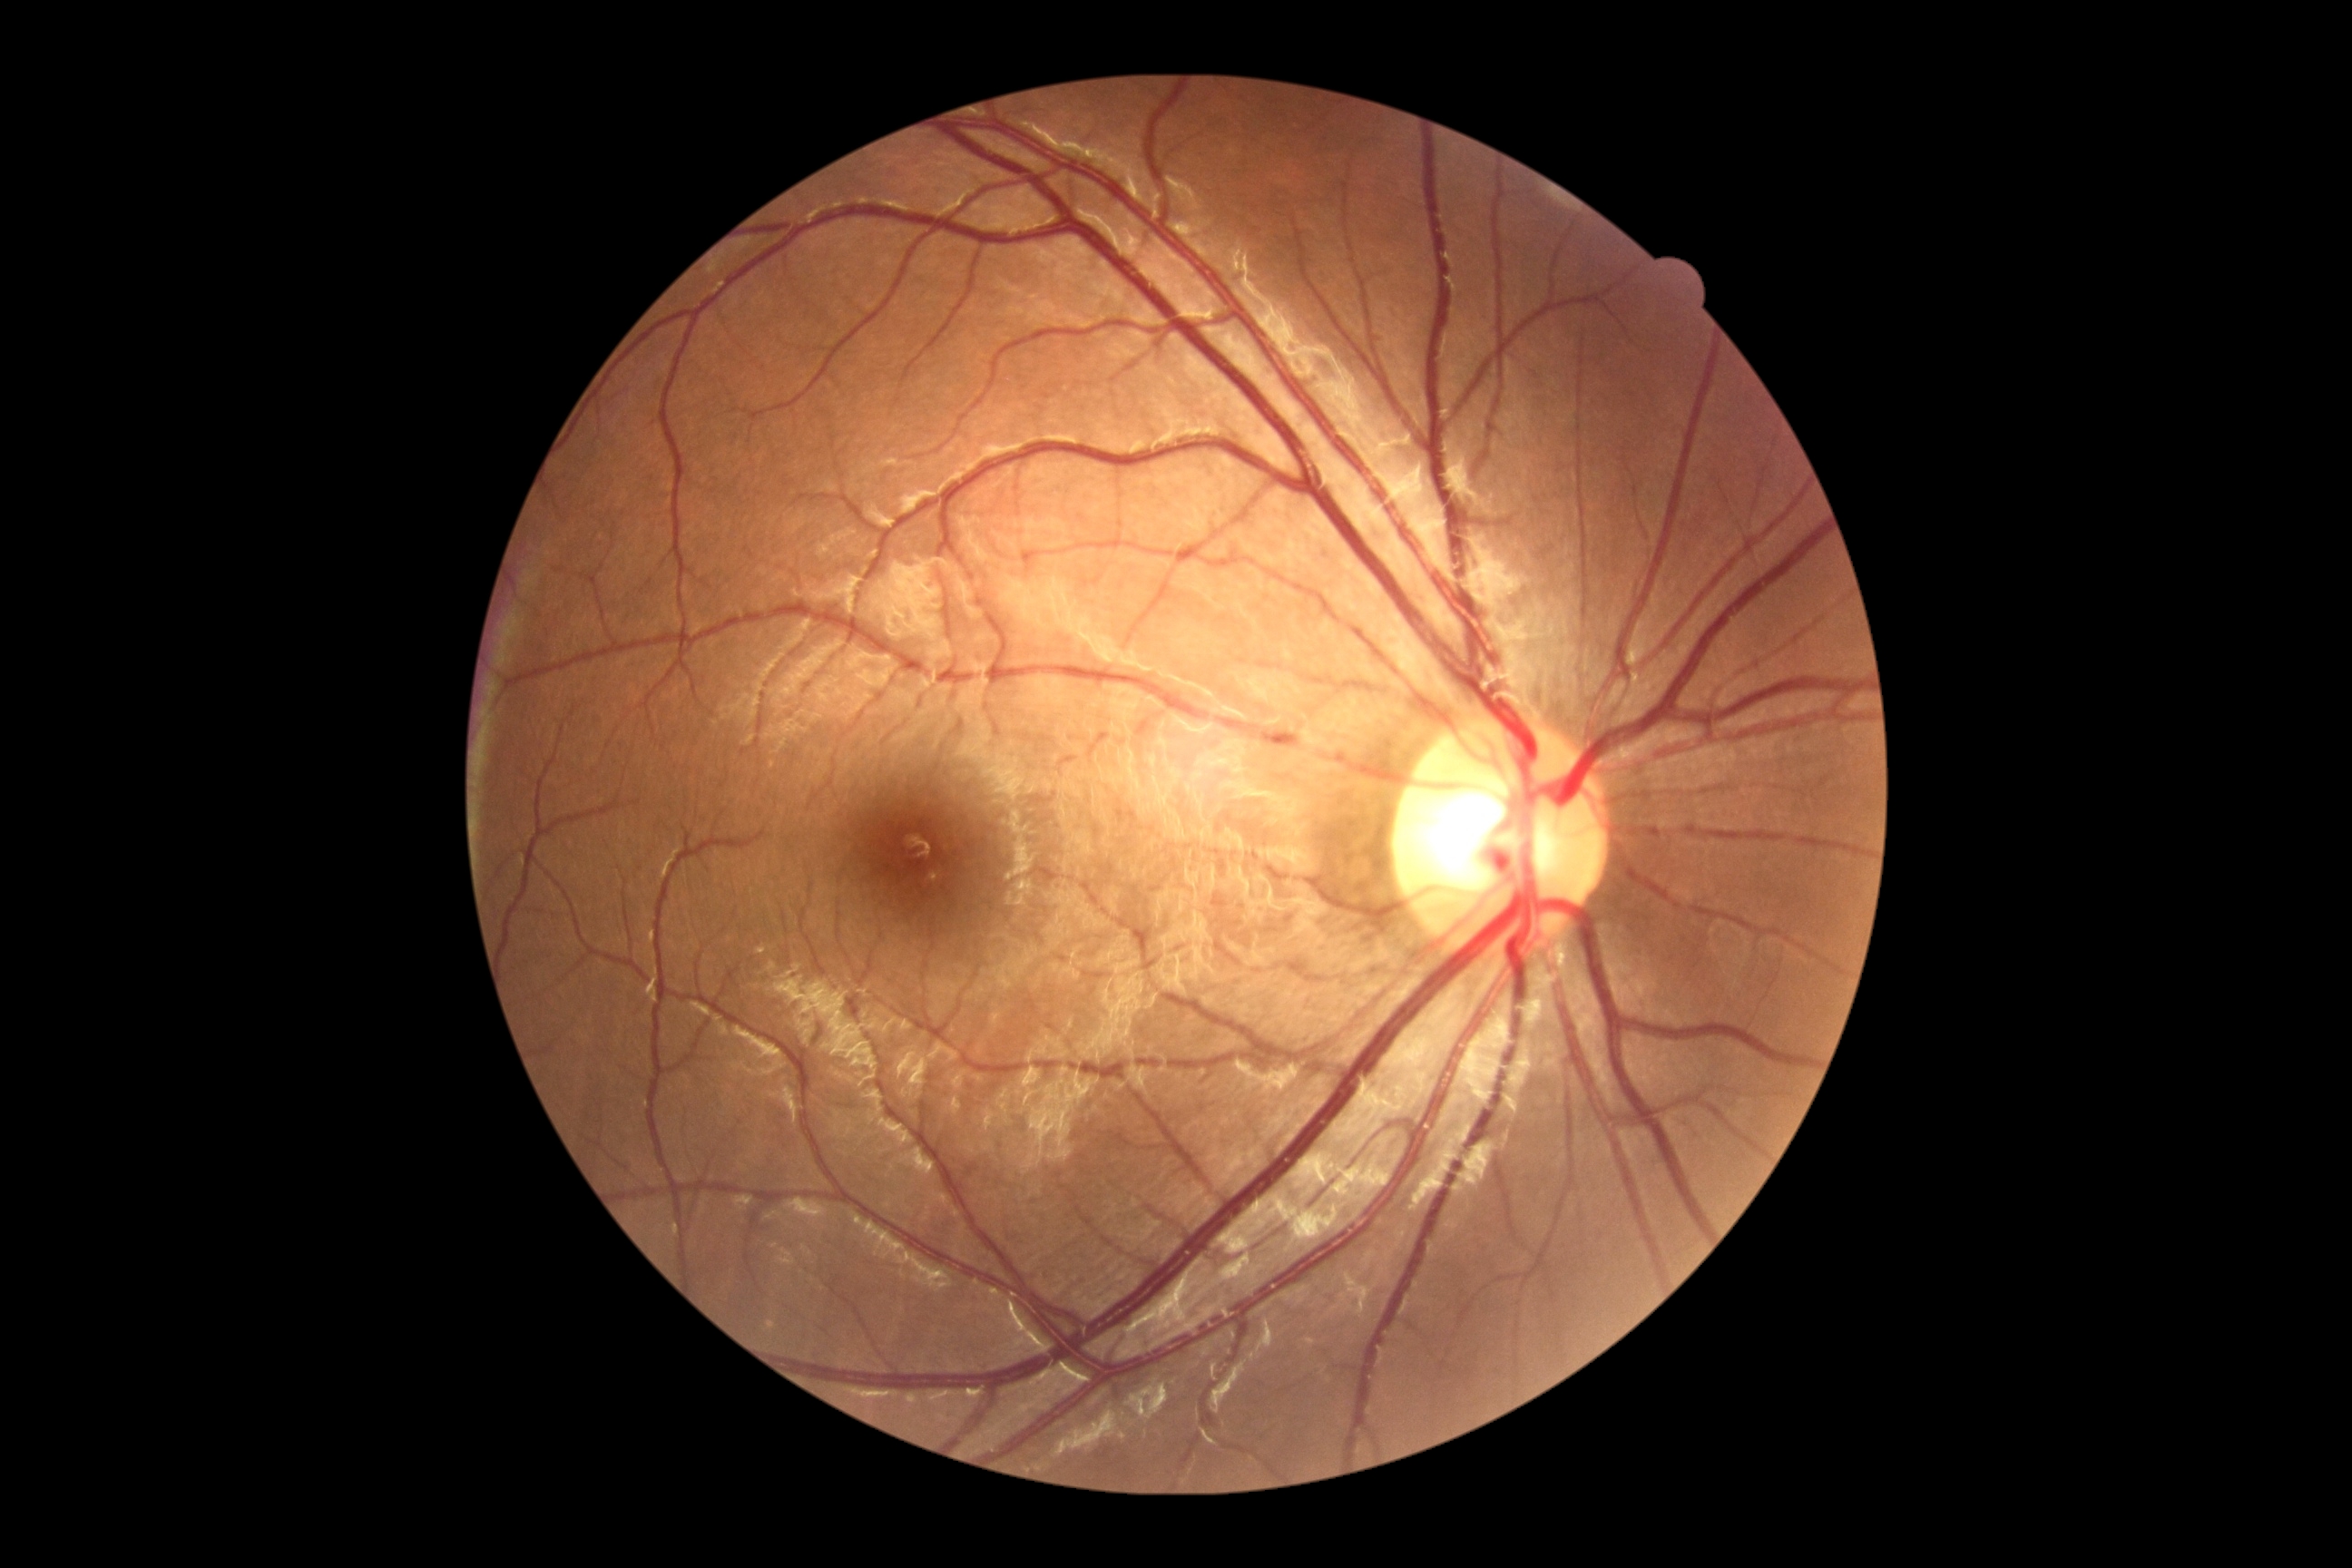 Annotations:
- diabetic retinopathy (DR) — 0/4